ONH-centered crop from a color fundus image
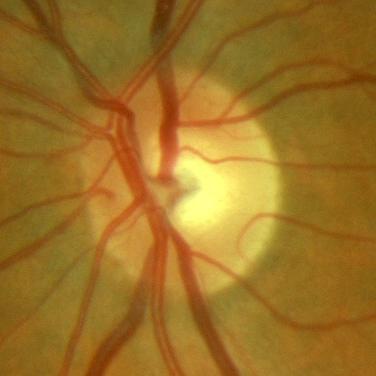 Assessment = no signs of glaucoma.